UWF retinal mosaic: 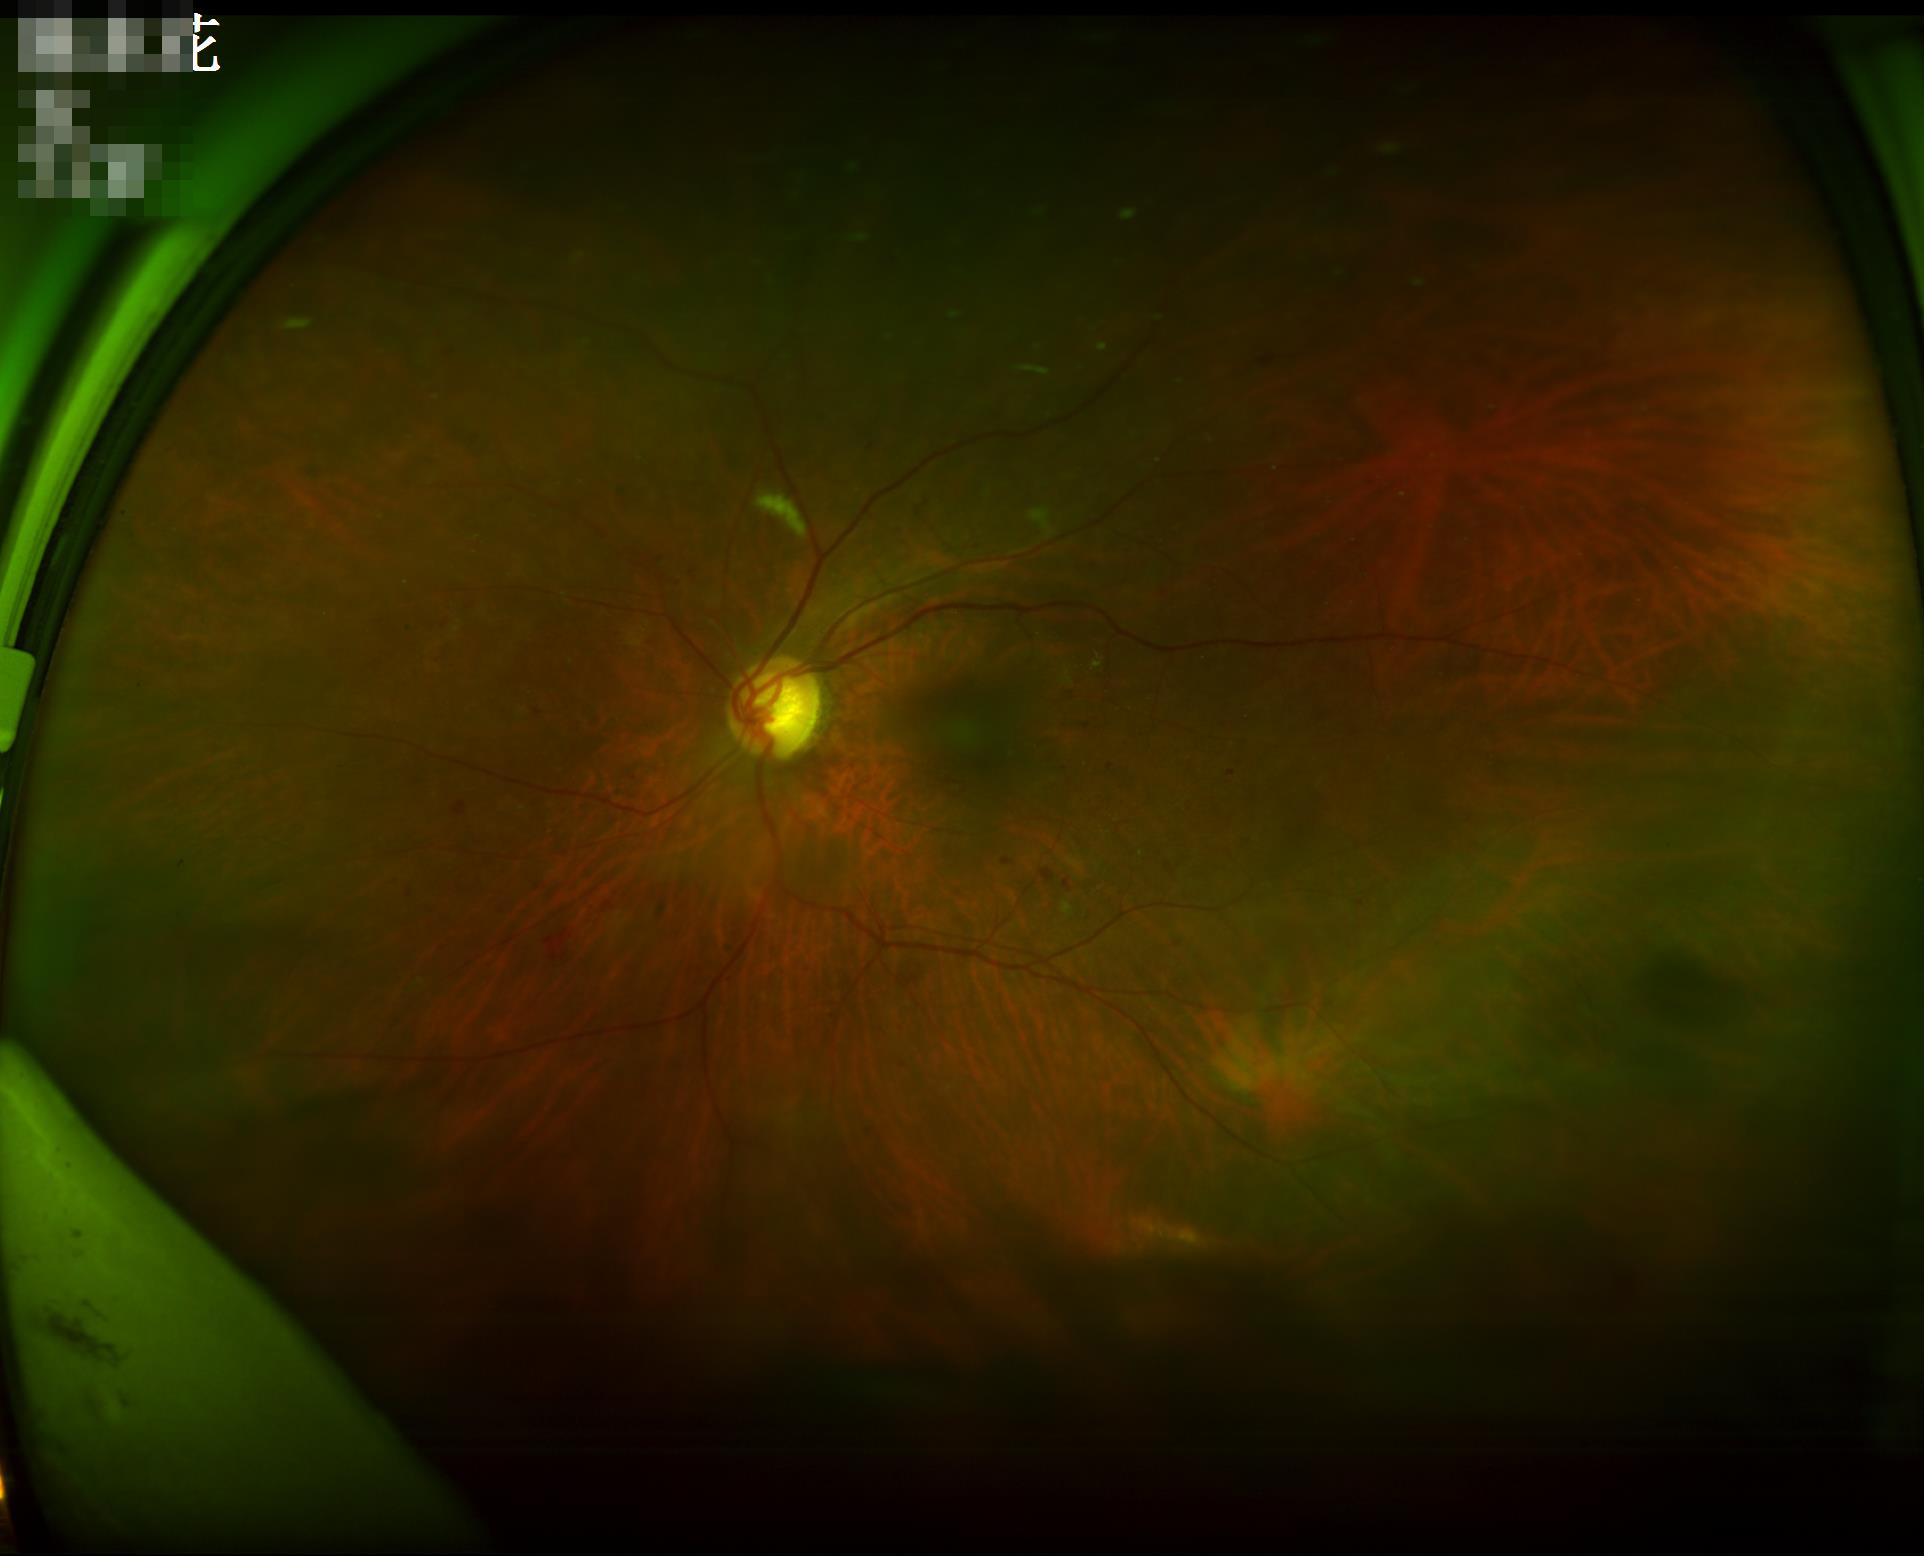 illumination: suboptimal
clarity: good
contrast: satisfactory
overall_quality: suboptimal